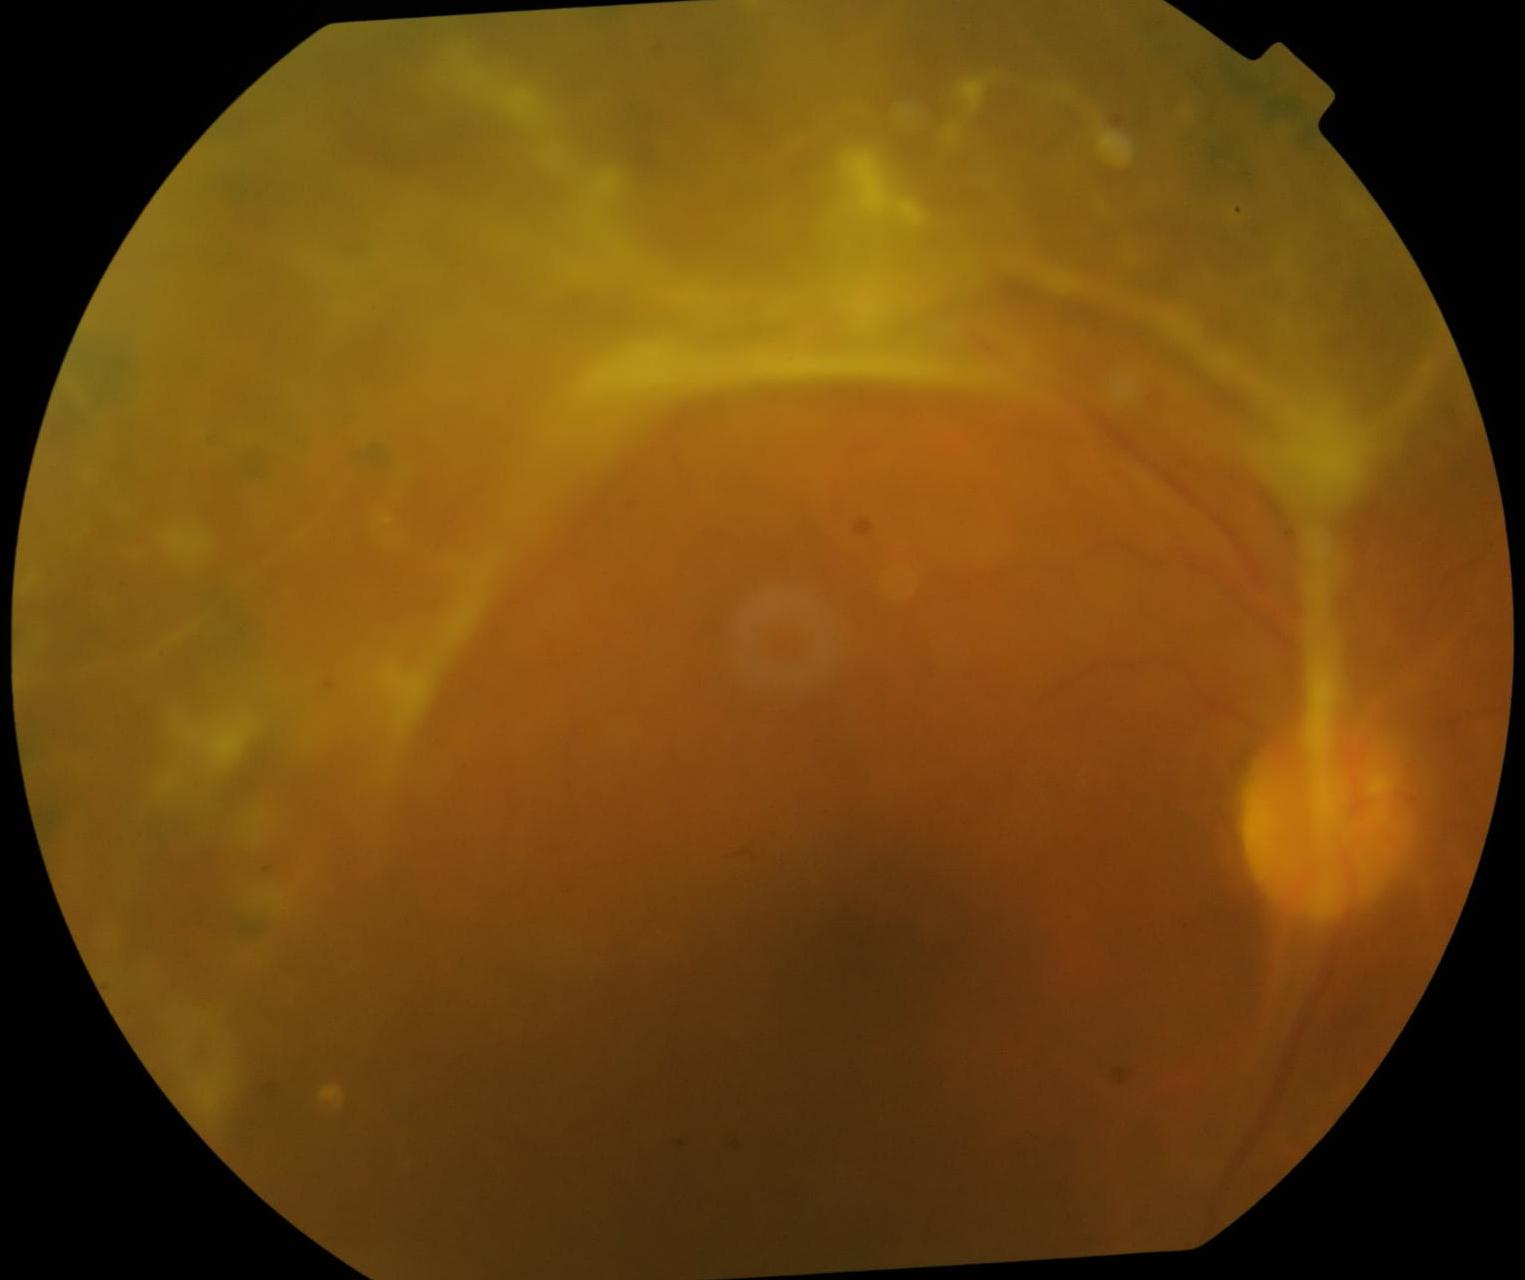 Diabetic retinopathy severity: grade 4 (PDR) — neovascularization and/or vitreous/pre-retinal hemorrhage.